848x848px
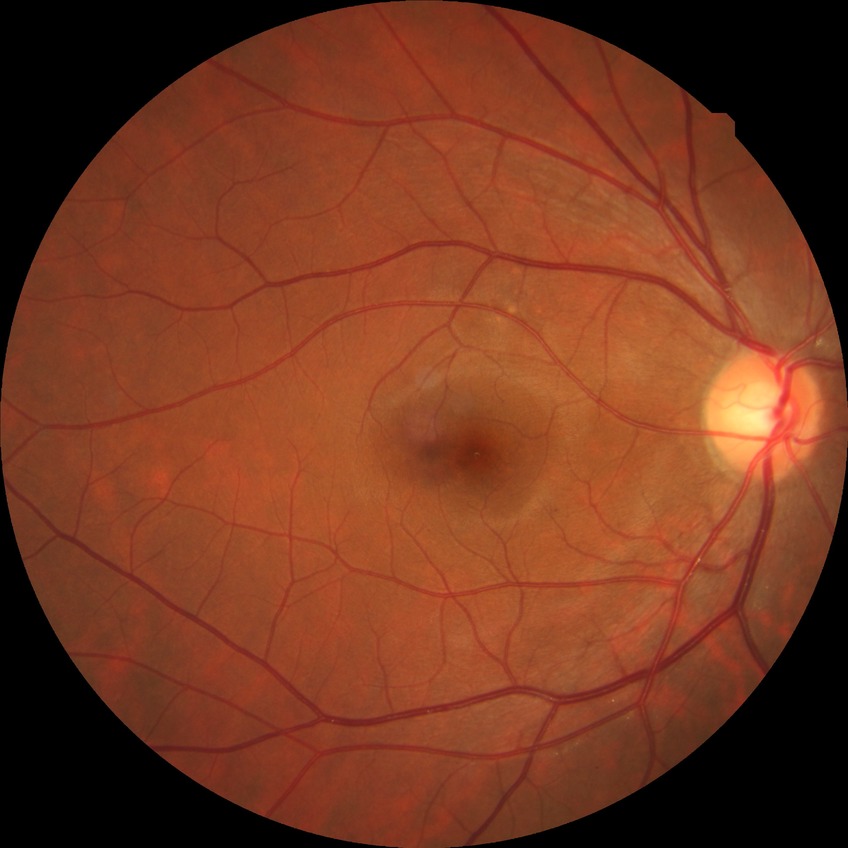

DR severity: NDR. No diabetic retinal disease findings.